45° FOV
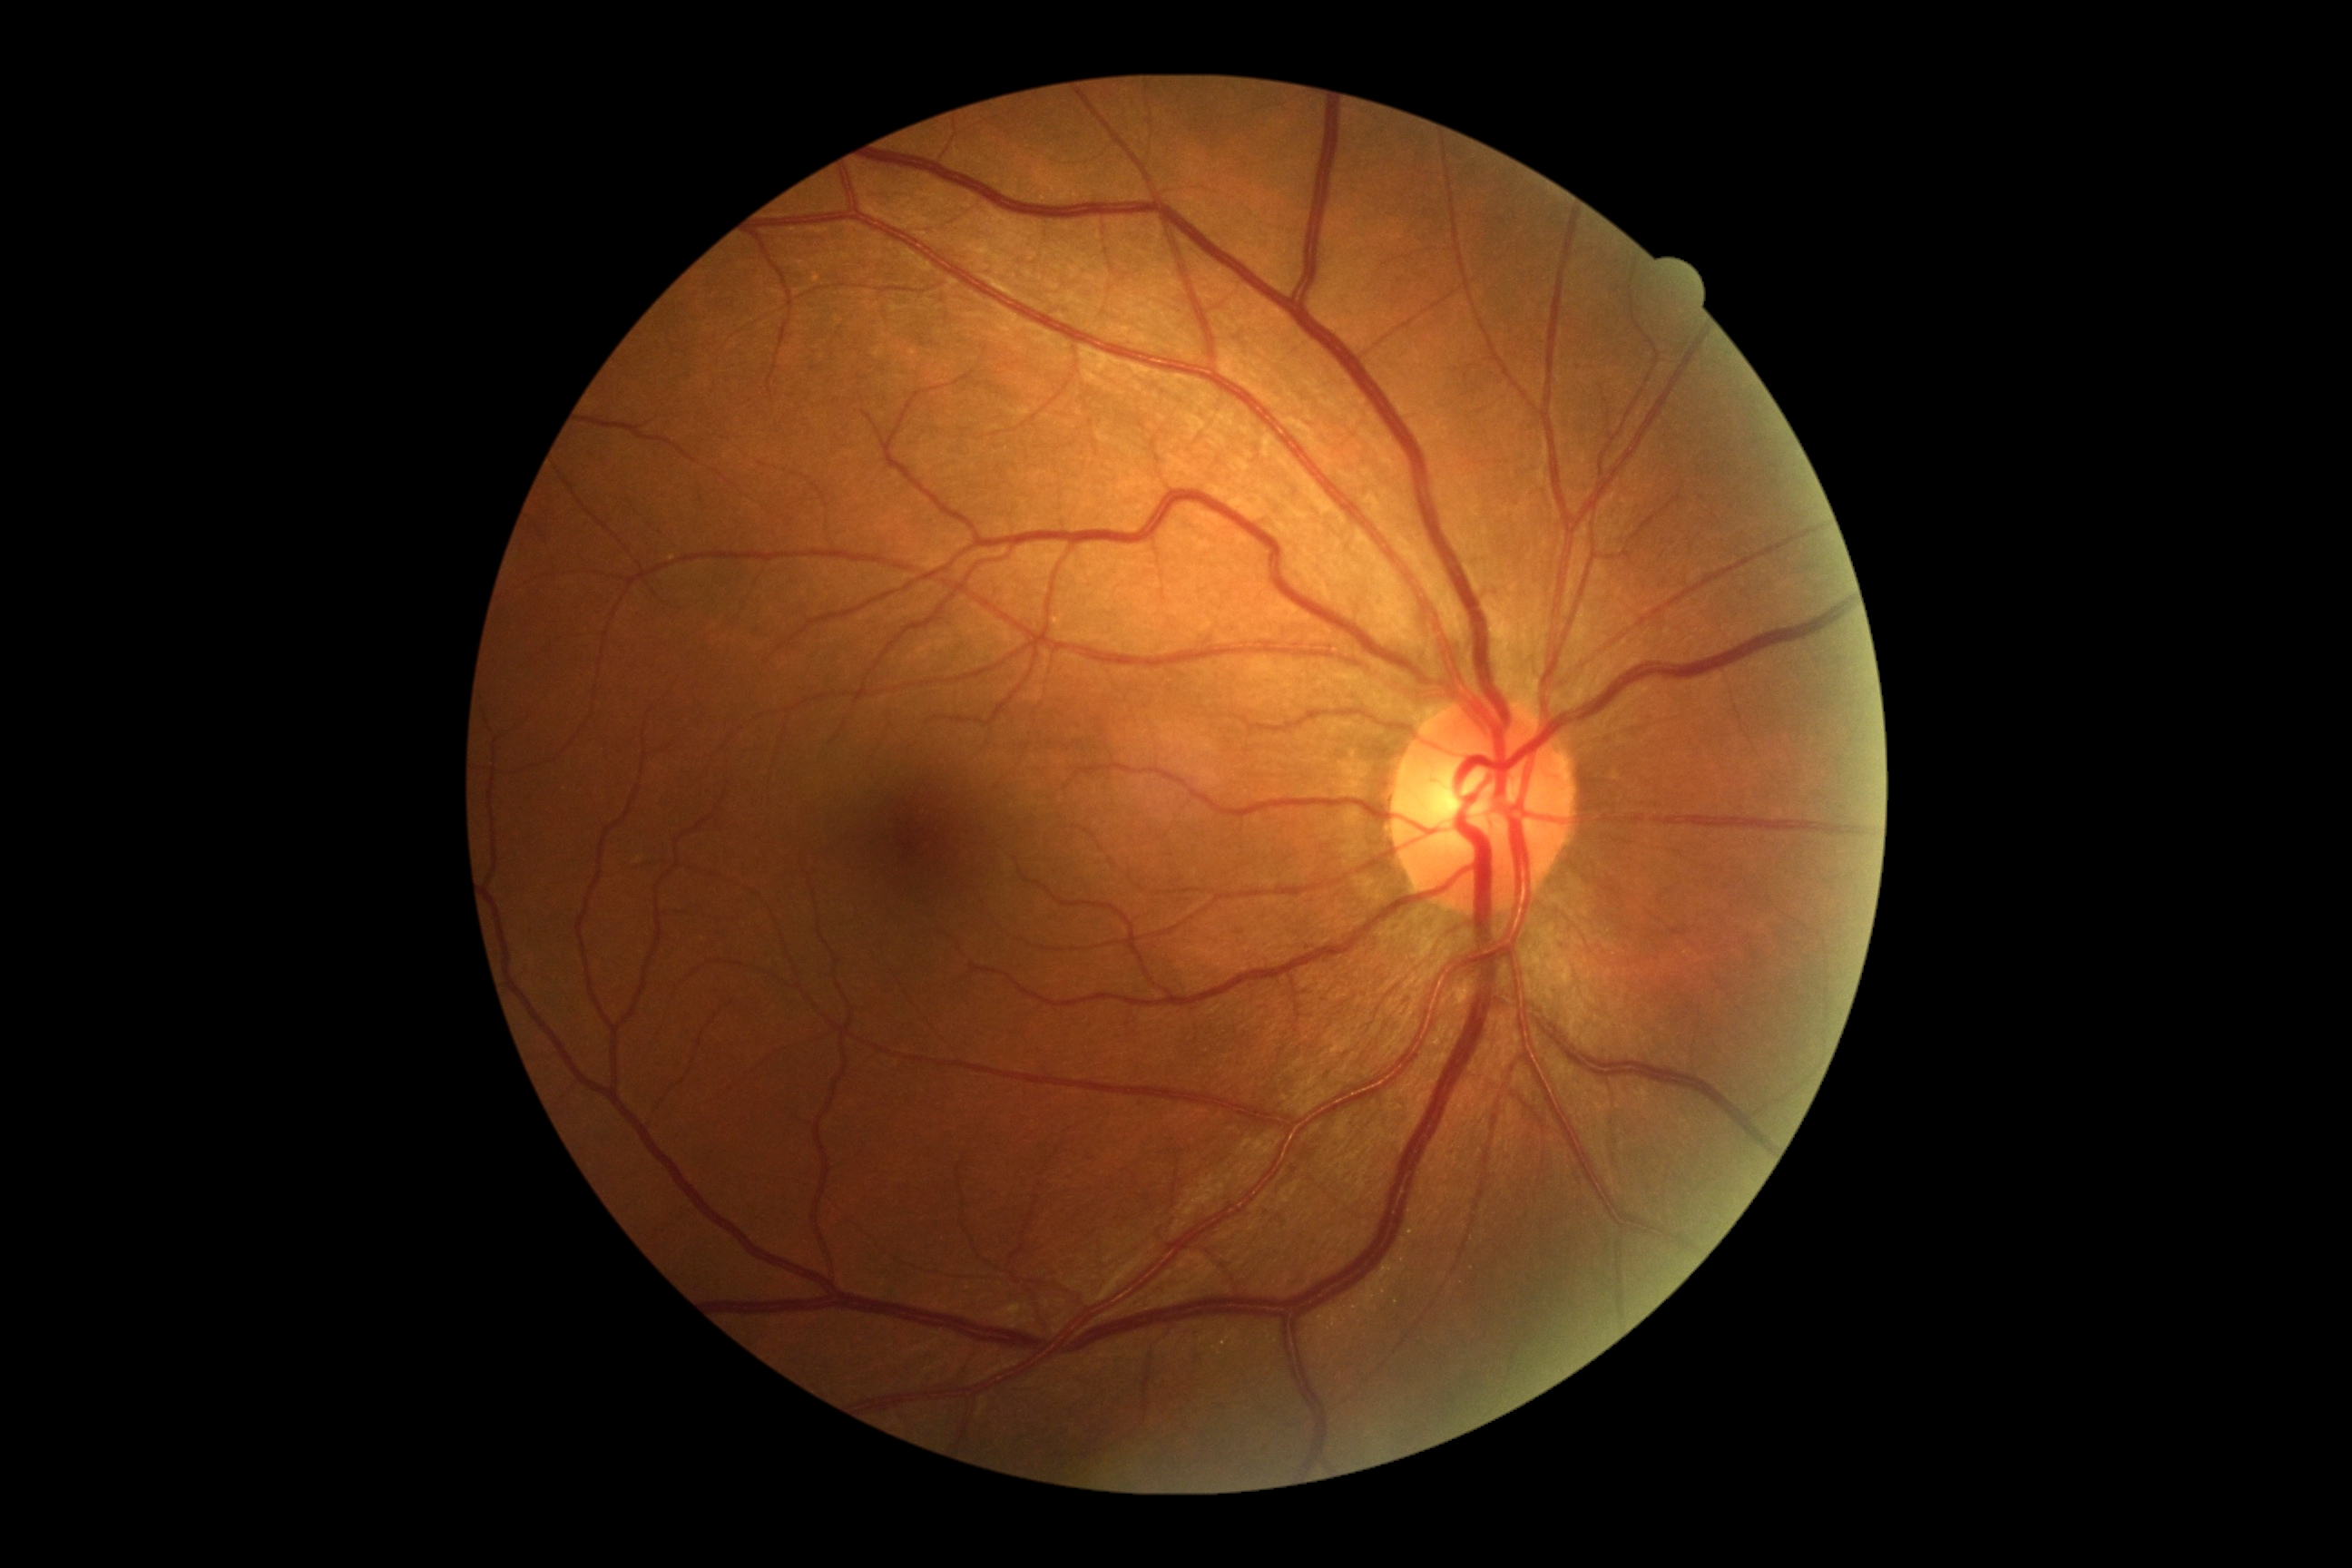
diabetic retinopathy severity = no apparent diabetic retinopathy (grade 0).